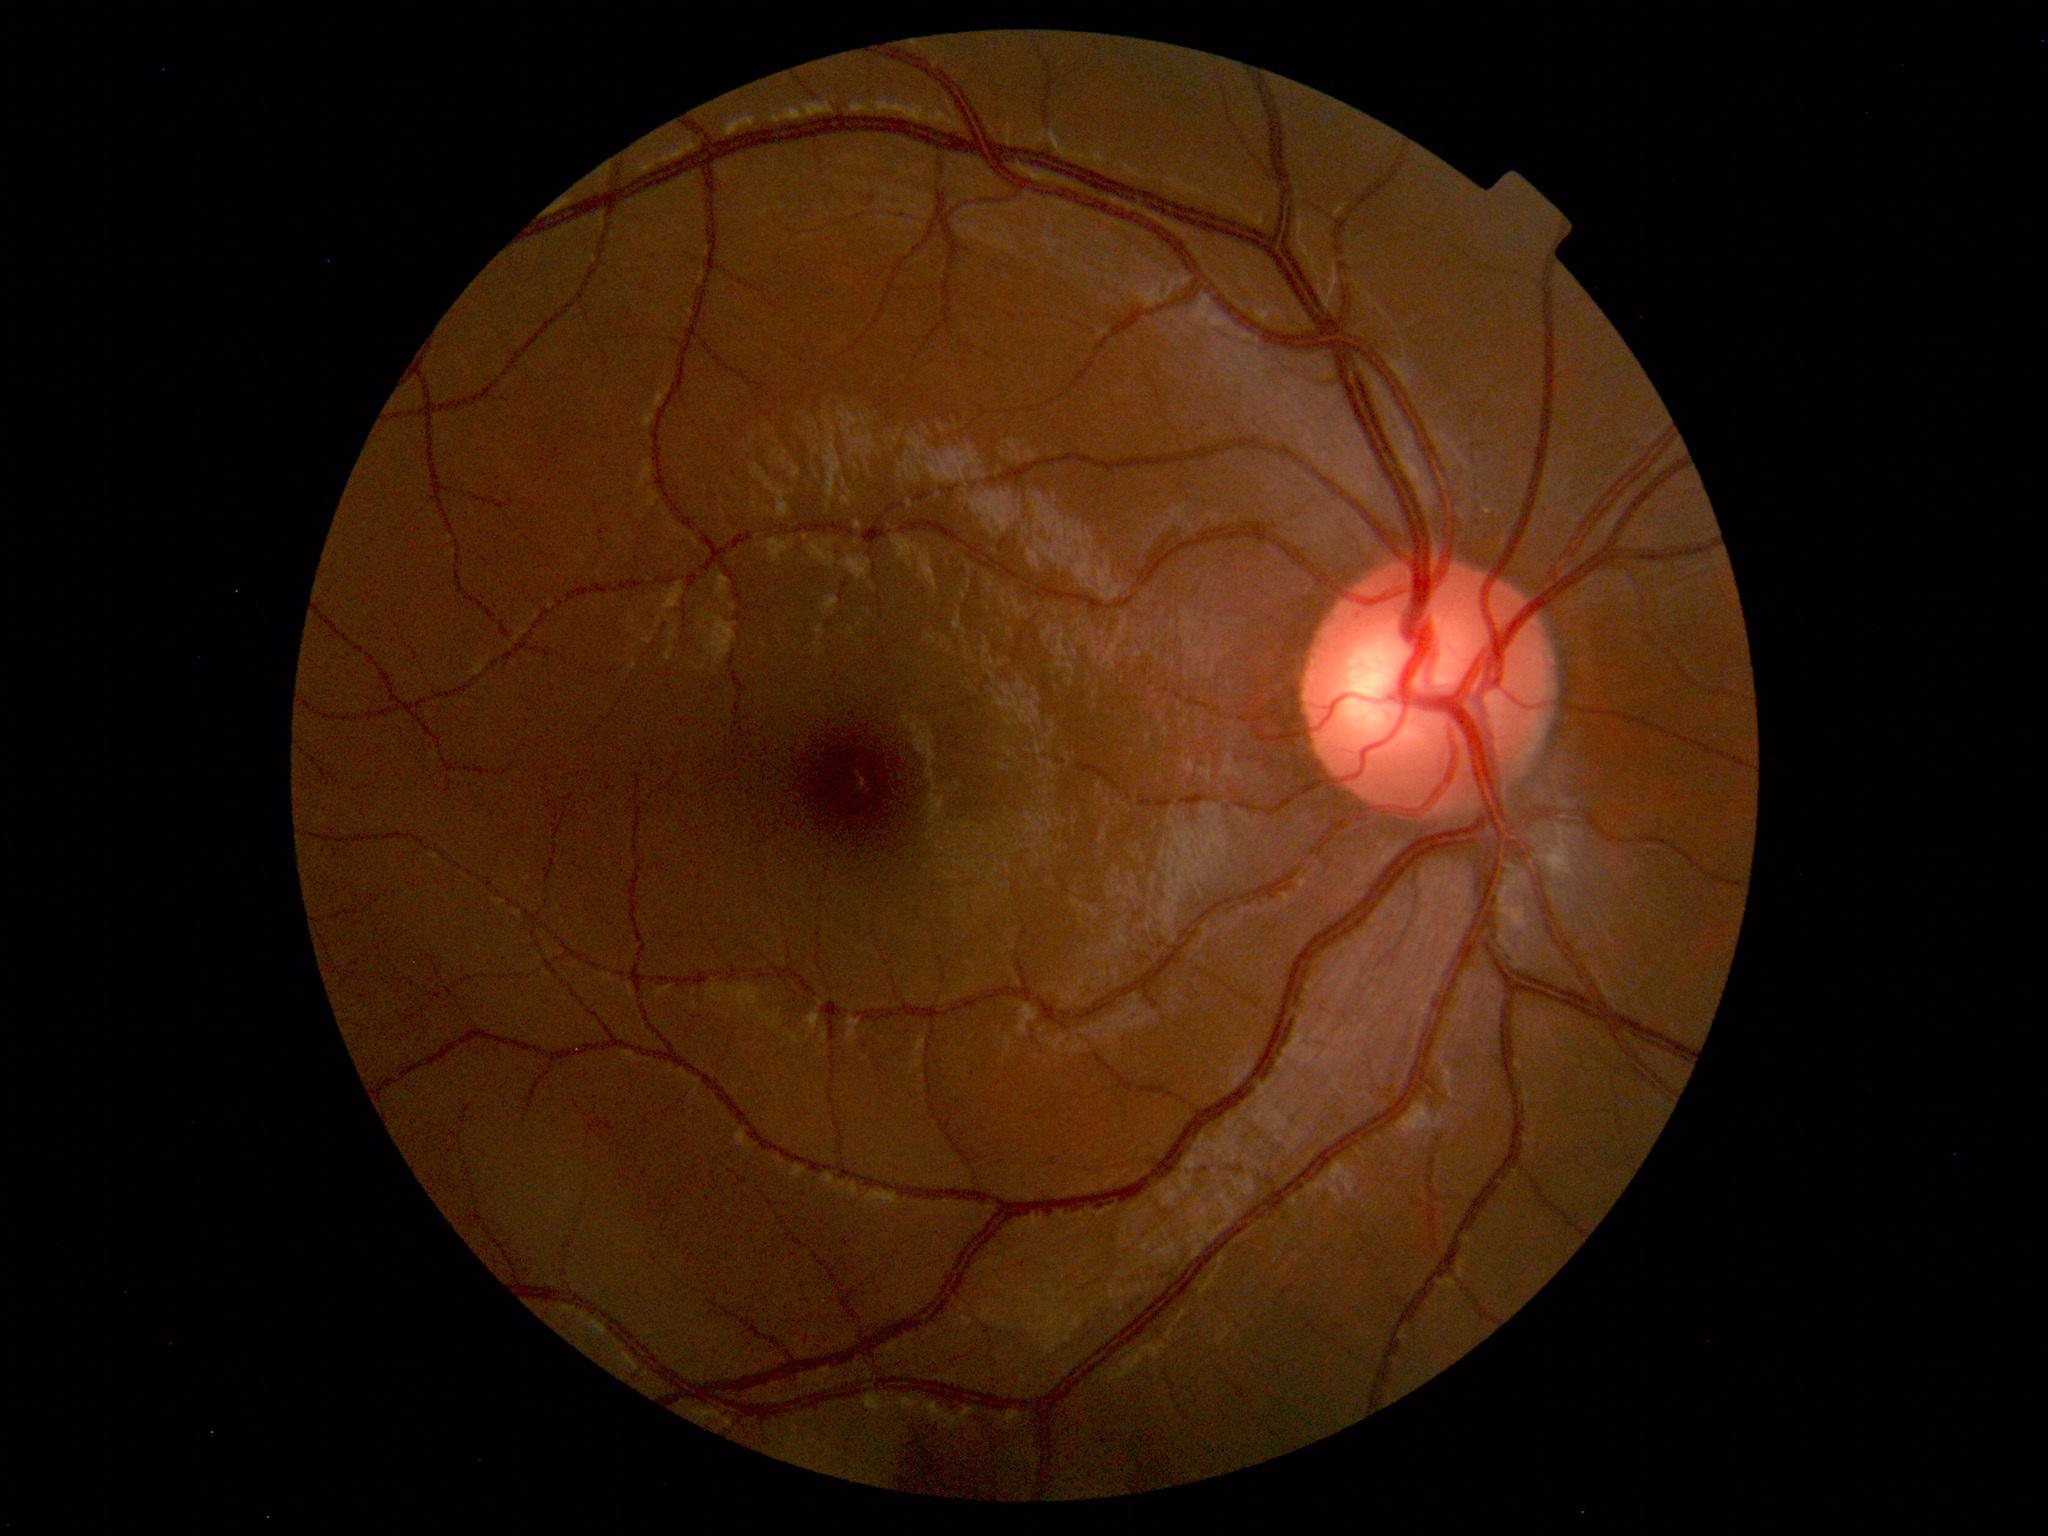 Normal fundus appearance.